Color fundus image
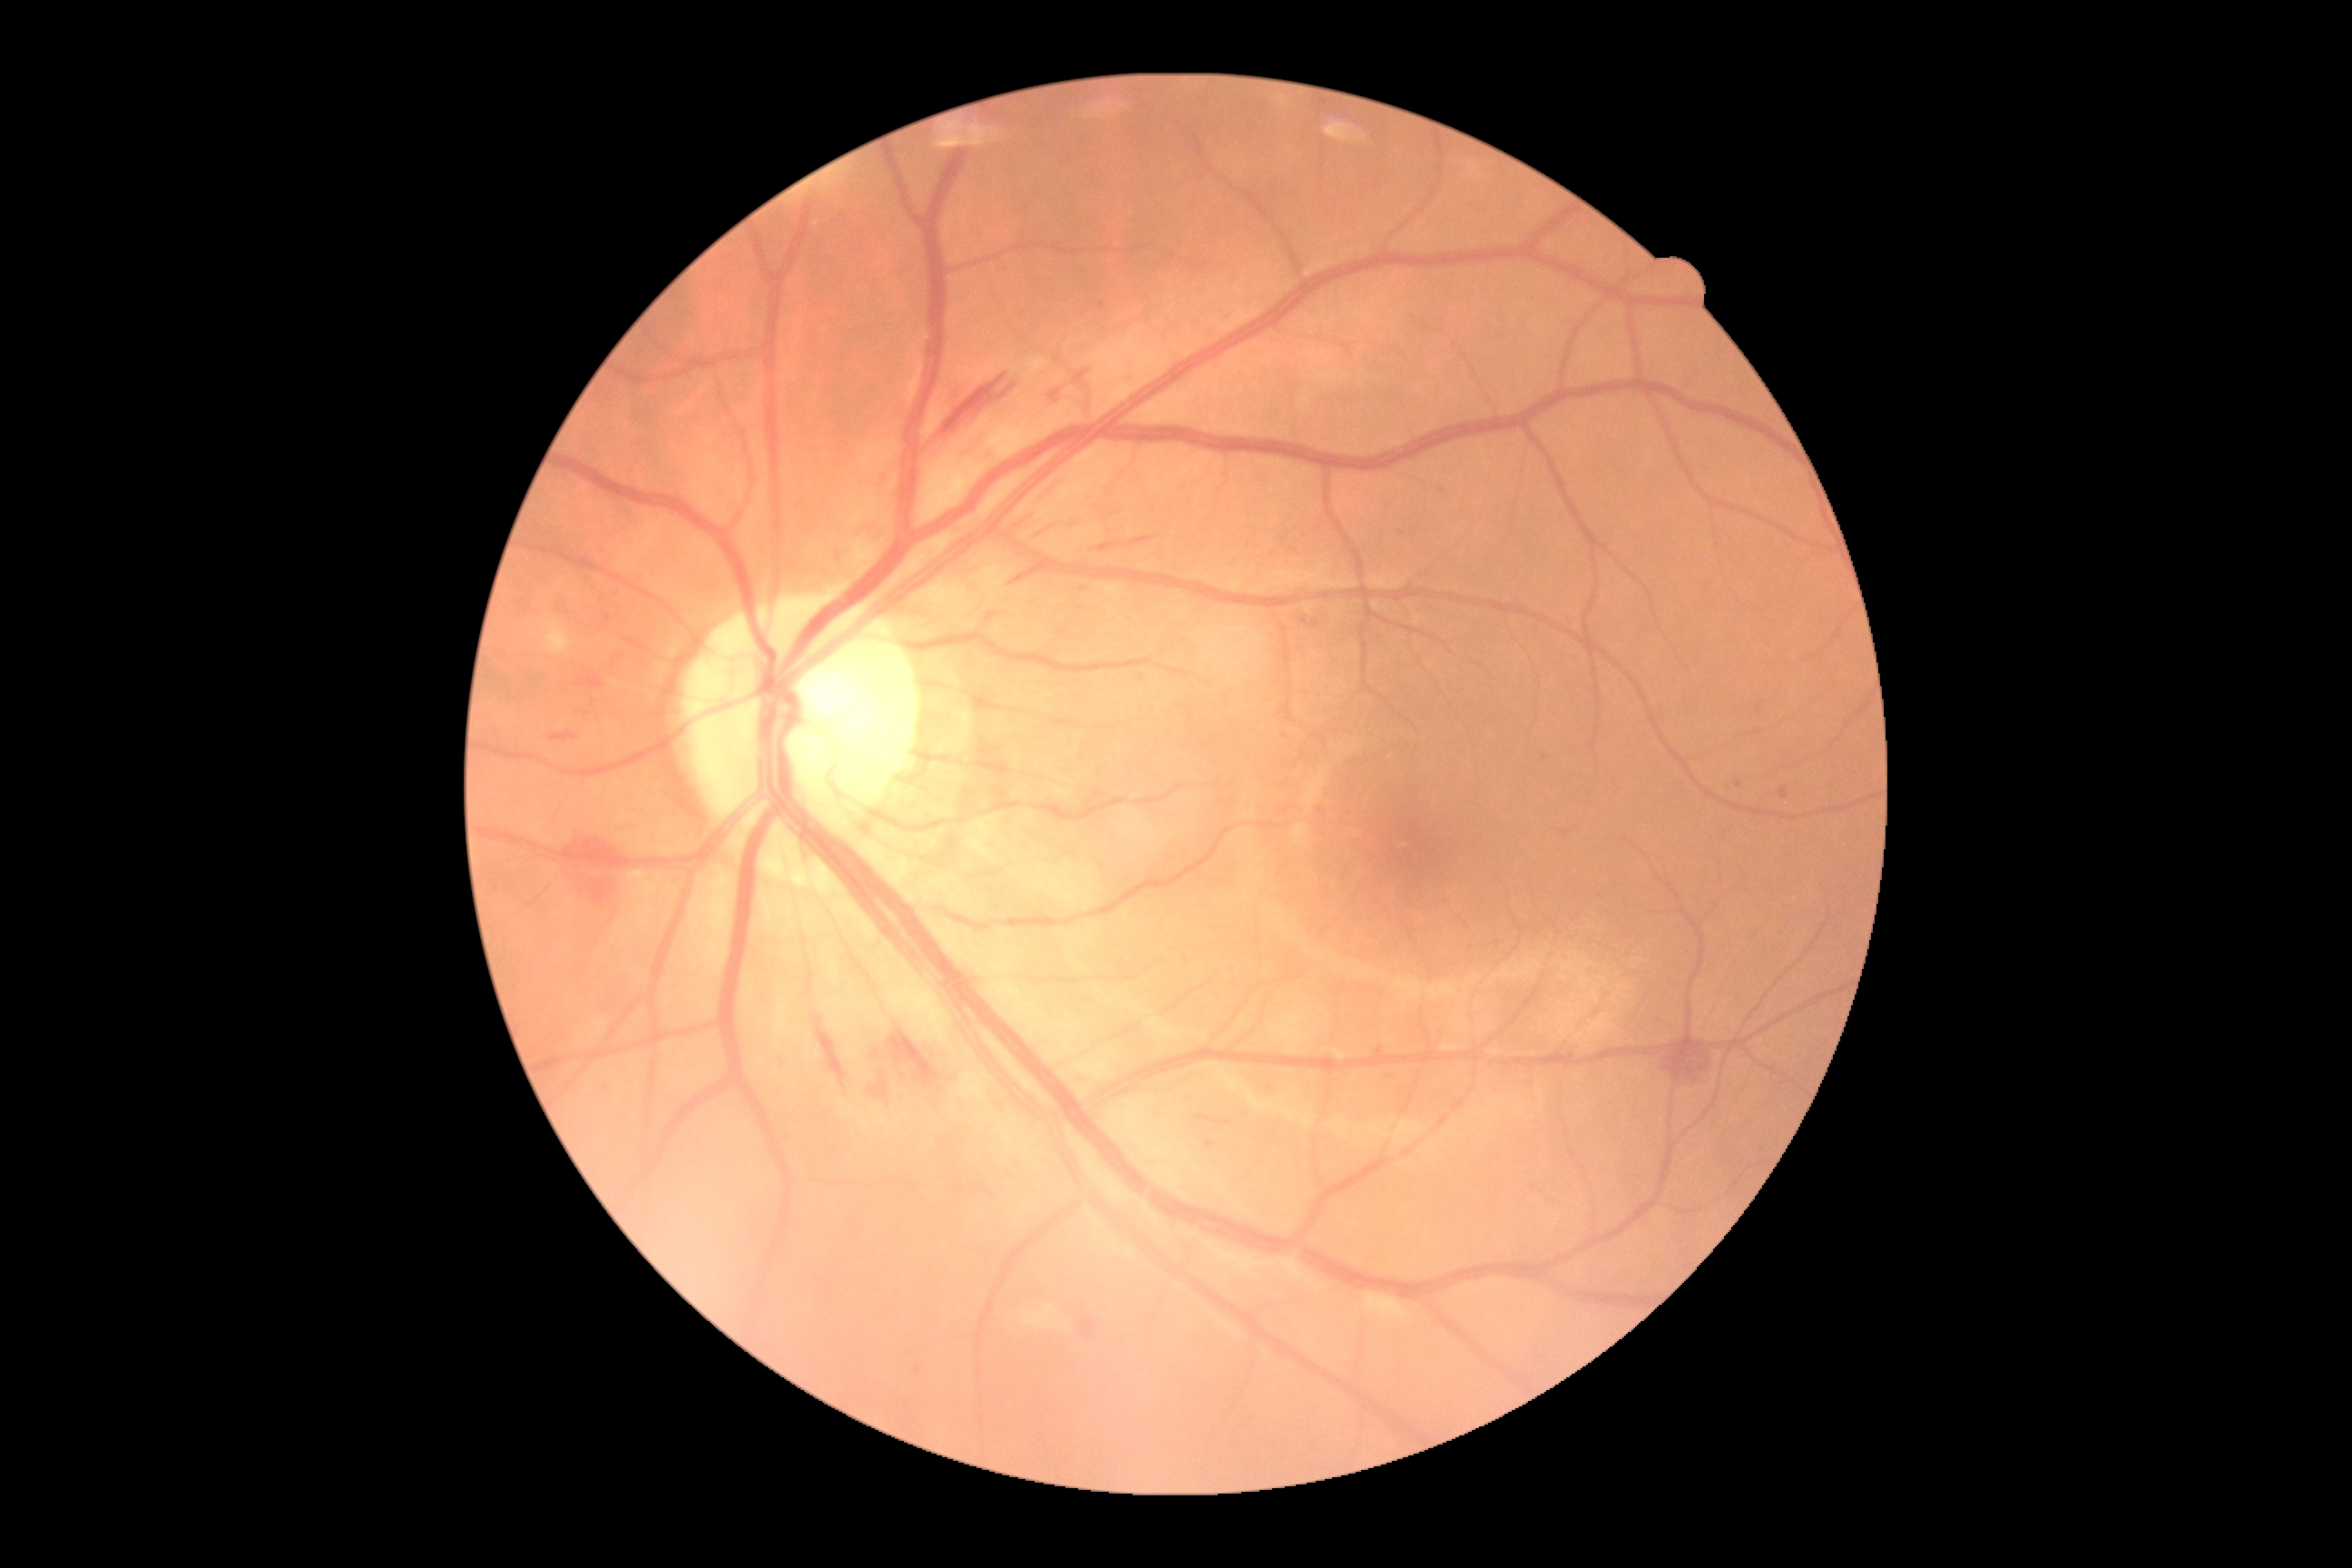

DR is moderate non-proliferative diabetic retinopathy (grade 2).